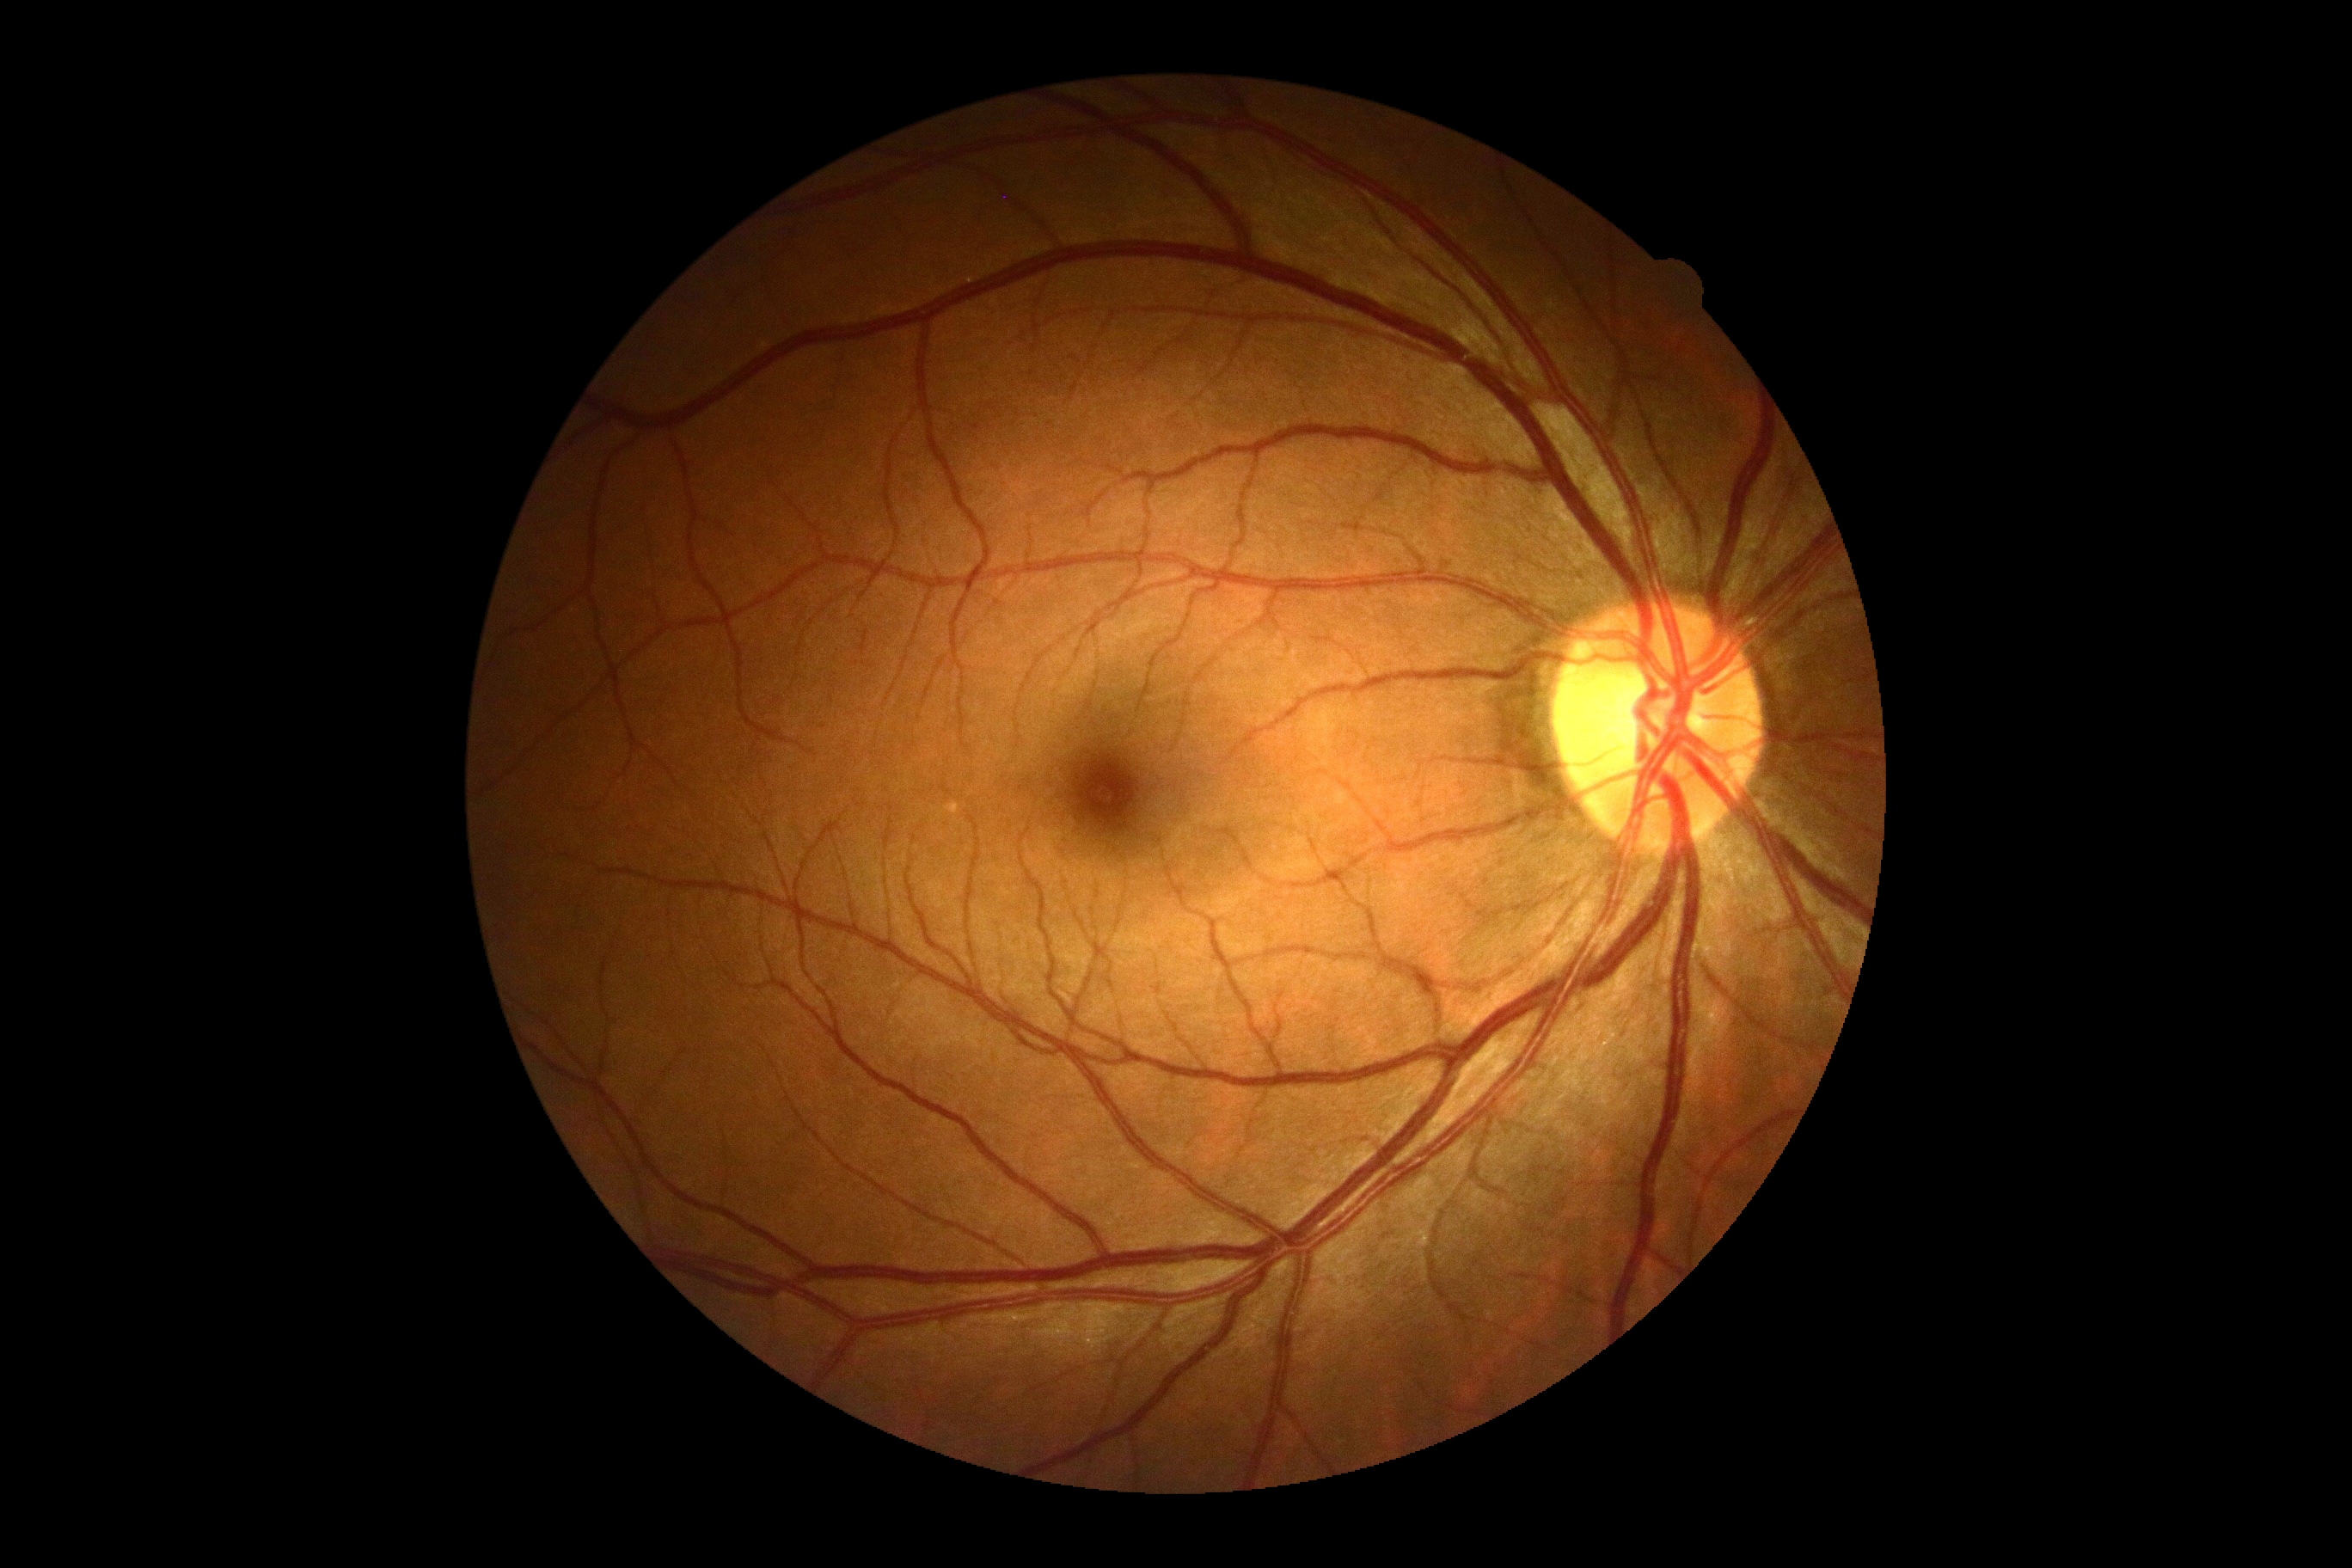

diabetic retinopathy severity: 0/4 — no visible signs of diabetic retinopathy.